45-degree field of view
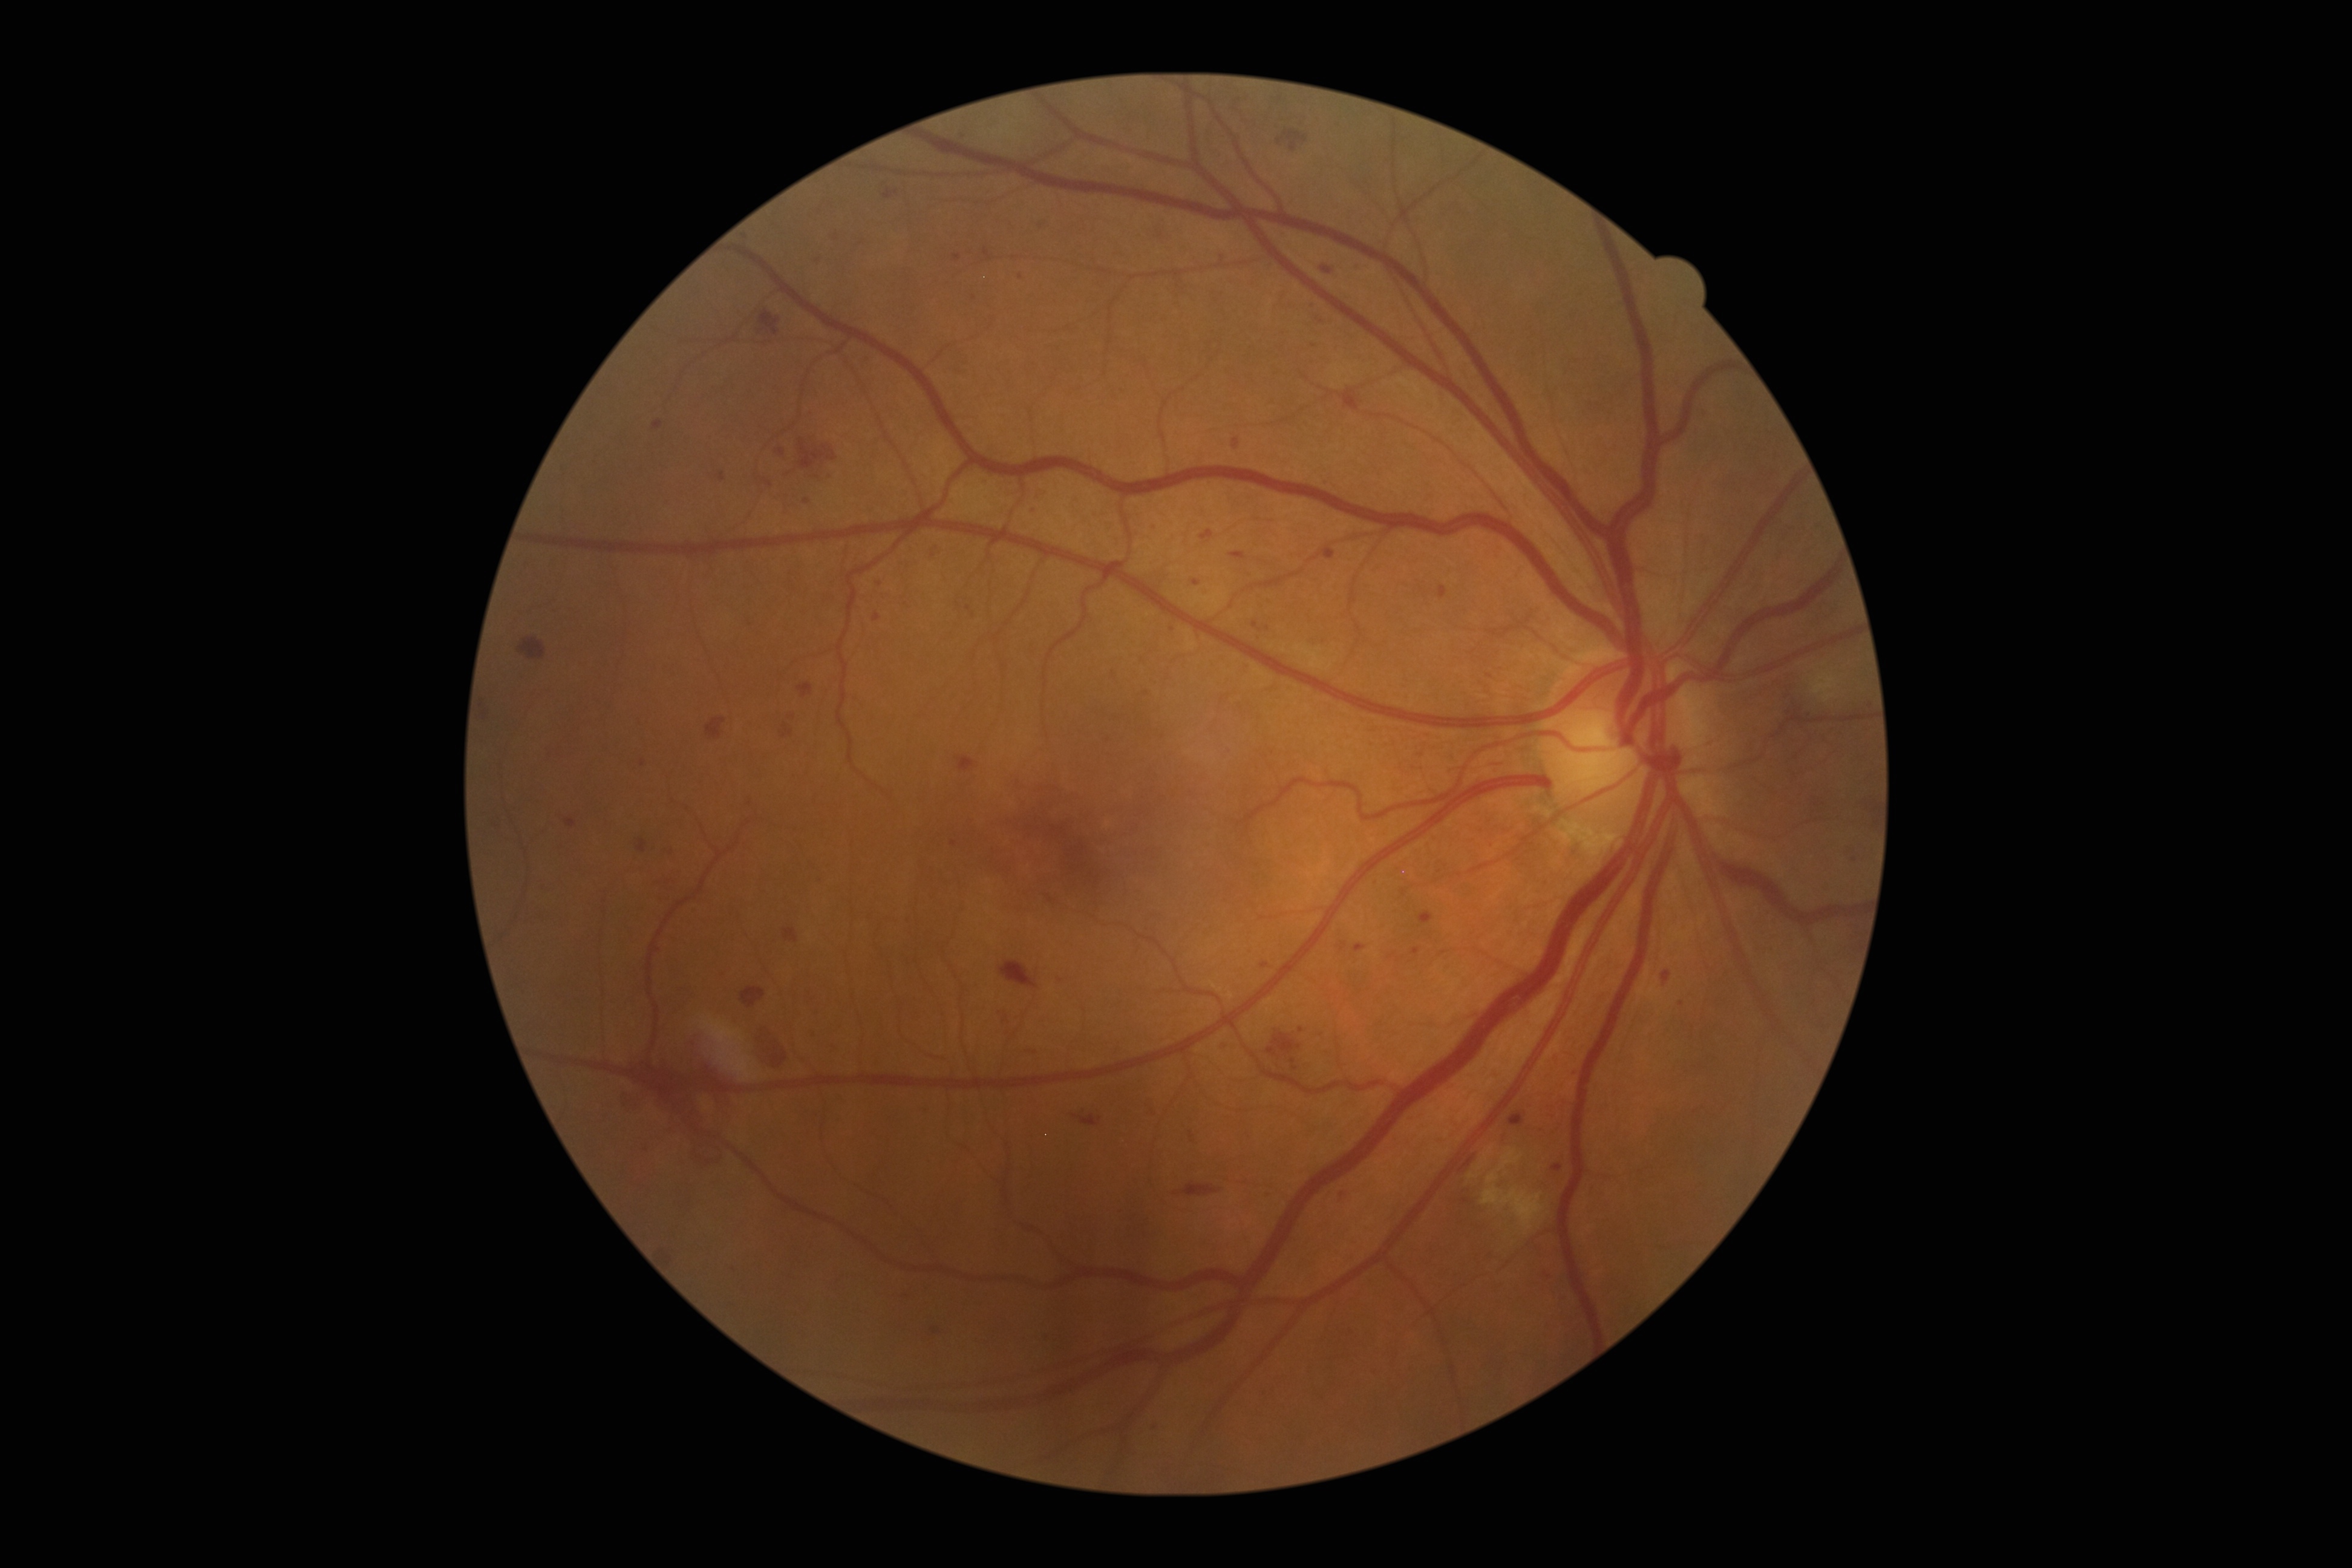

Diabetic retinopathy (DR) is grade 3 (severe NPDR) — more than 20 intraretinal hemorrhages in each of 4 quadrants, definite venous beading in 2 or more quadrants, or prominent intraretinal microvascular abnormalities in 1 or more quadrants, with no signs of proliferative retinopathy; non-proliferative diabetic retinopathy. Microaneurysms (MAs) include those at [left=1253, top=621, right=1258, bottom=629] | [left=884, top=191, right=898, bottom=200] | [left=566, top=820, right=577, bottom=828] | [left=1552, top=1165, right=1563, bottom=1172] | [left=983, top=249, right=991, bottom=261] | [left=1045, top=1334, right=1050, bottom=1342] | [left=797, top=683, right=812, bottom=699] | [left=782, top=724, right=794, bottom=739] | [left=1152, top=1421, right=1160, bottom=1429] | [left=953, top=255, right=961, bottom=261]. Small MAs near [x=669, y=853] | [x=969, y=608] | [x=1222, y=258] | [x=909, y=1297] | [x=960, y=134] | [x=1876, y=809] | [x=1154, y=529].